Image size 2352x1568 — 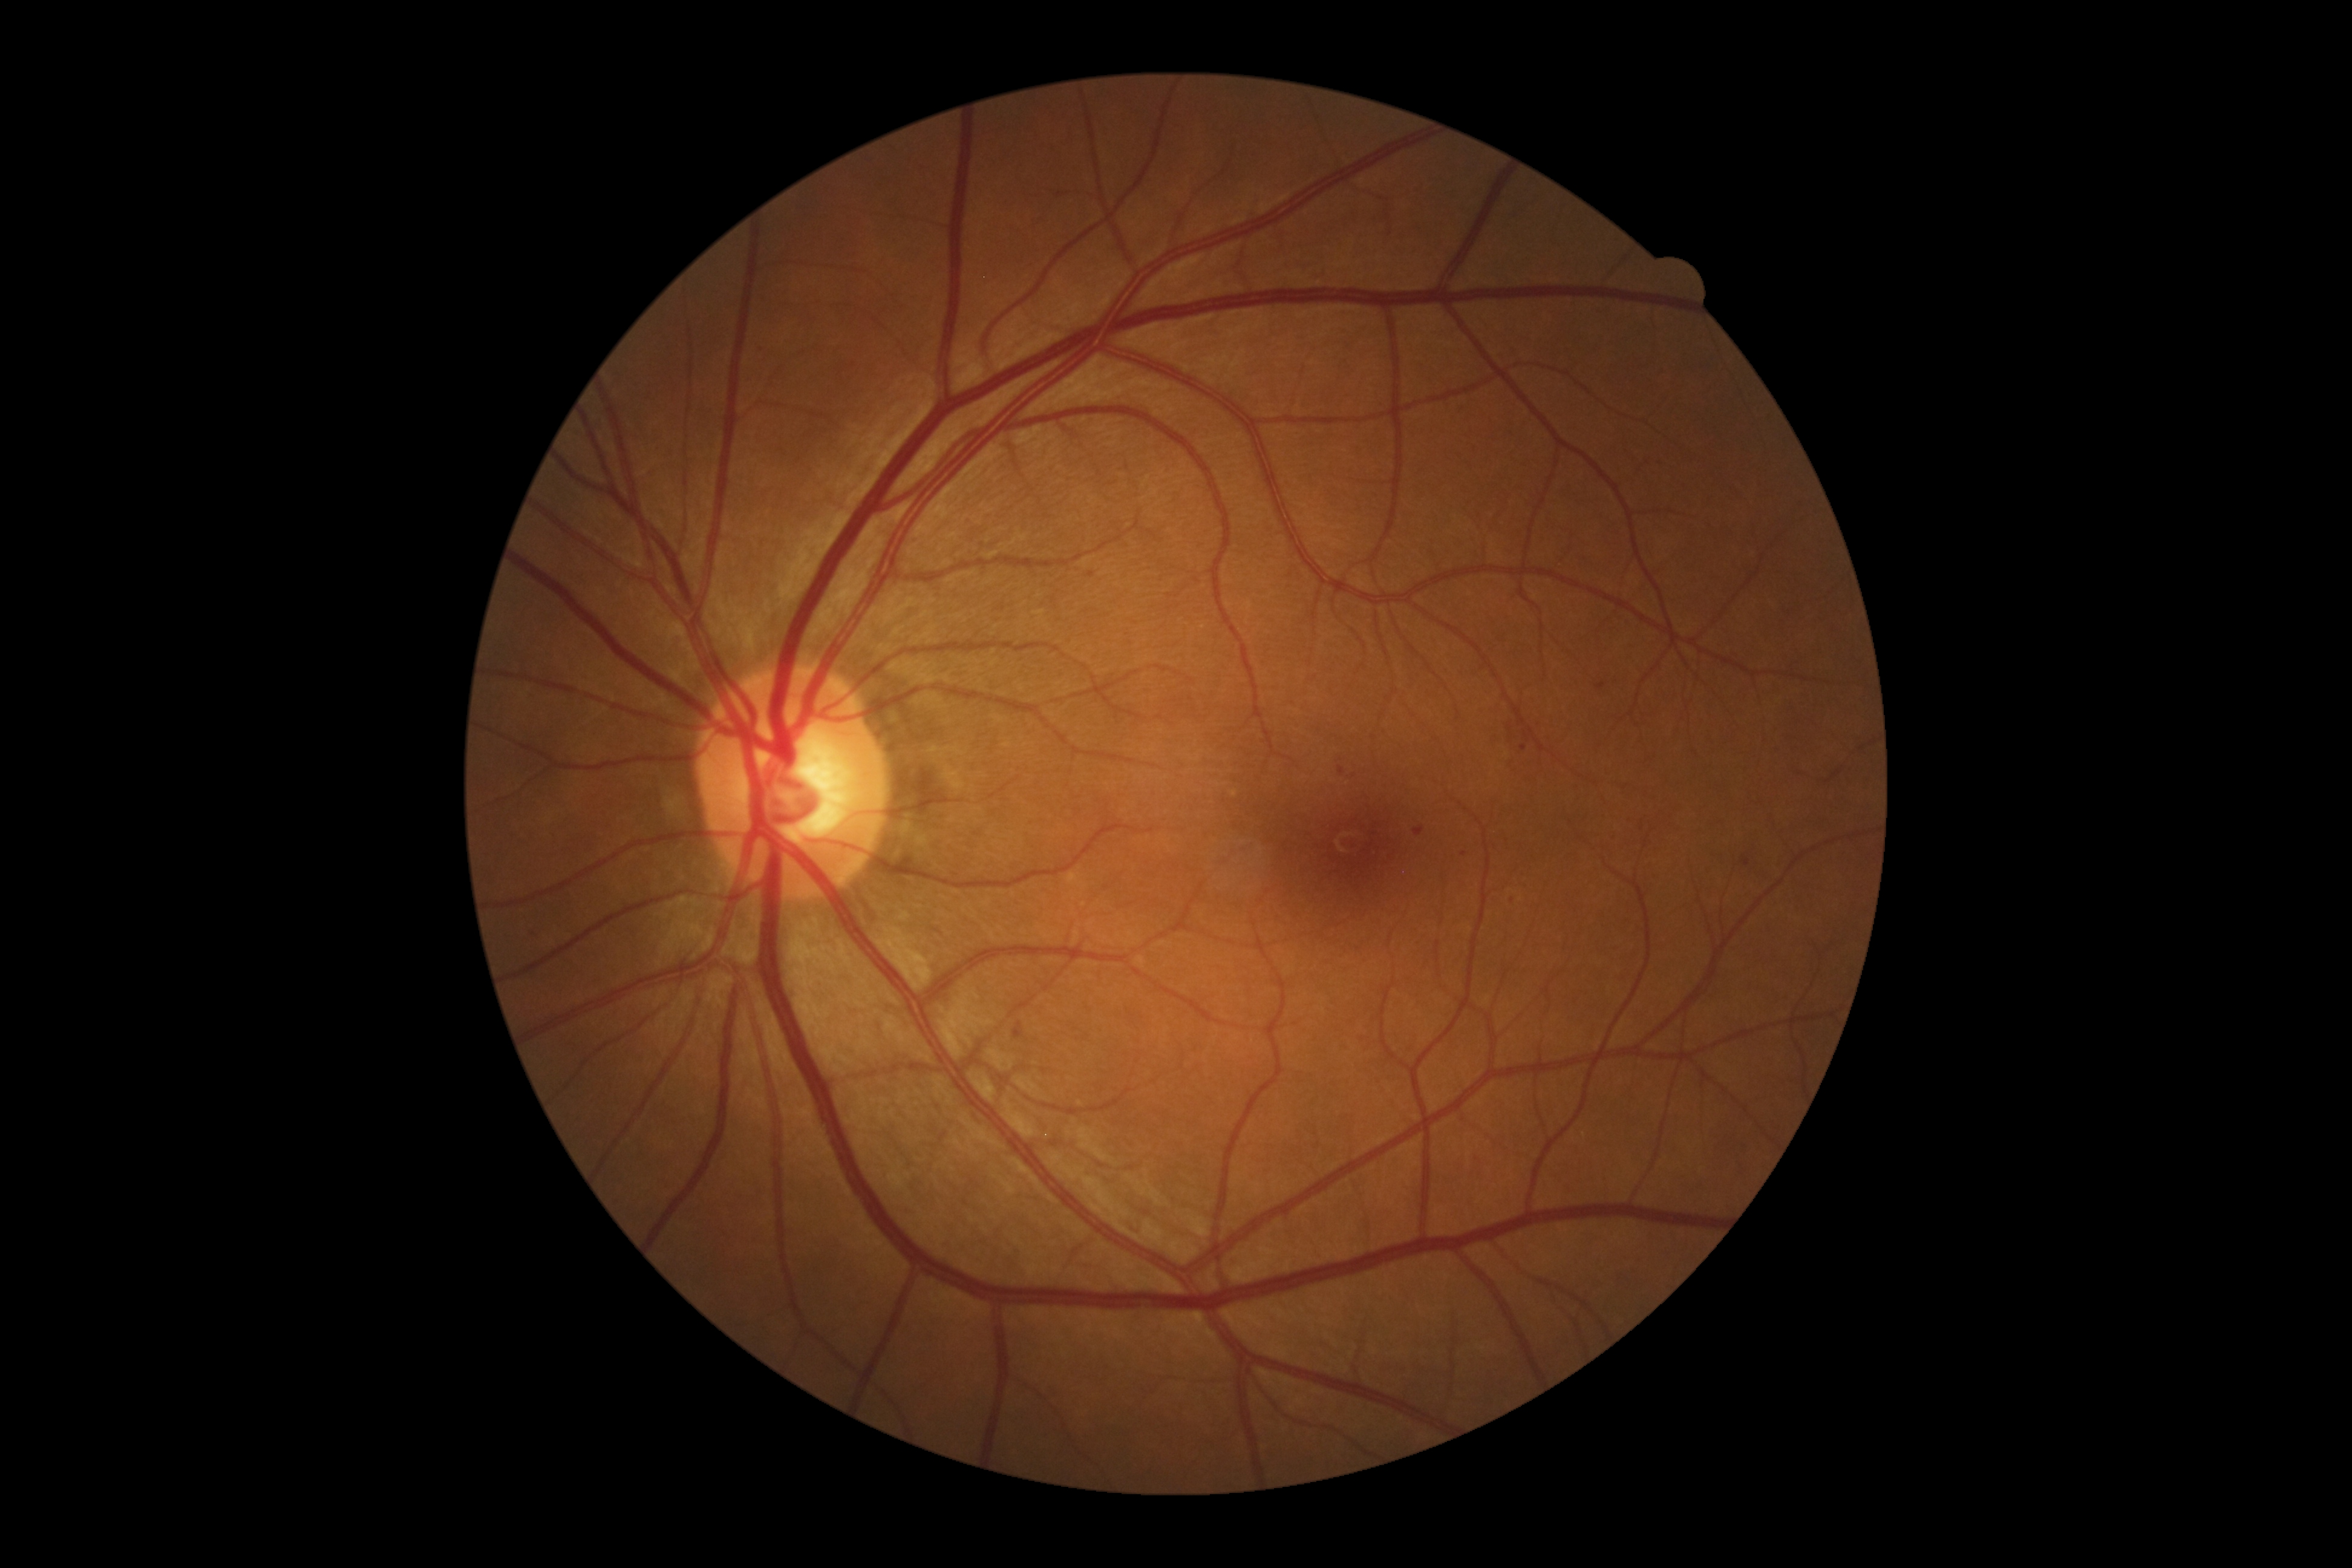

Diabetic retinopathy (DR): 1 — presence of microaneurysms only
Representative lesions:
soft exudates (SEs): not present
microaneurysms (MAs) (subset): left=1524, top=731, right=1529, bottom=740, left=1338, top=766, right=1345, bottom=775, left=1414, top=827, right=1425, bottom=837, left=528, top=927, right=537, bottom=935, left=1742, top=856, right=1750, bottom=867, left=1013, top=1022, right=1023, bottom=1039, left=1595, top=682, right=1606, bottom=689
Smaller MAs around [1353, 773], [1464, 854], [938, 930], [1523, 748], [1510, 727], [1091, 575]
hemorrhages (HEs): not present
hard exudates (EXs): not present